1240 x 1240 pixels; wide-field contact fundus photograph of an infant: 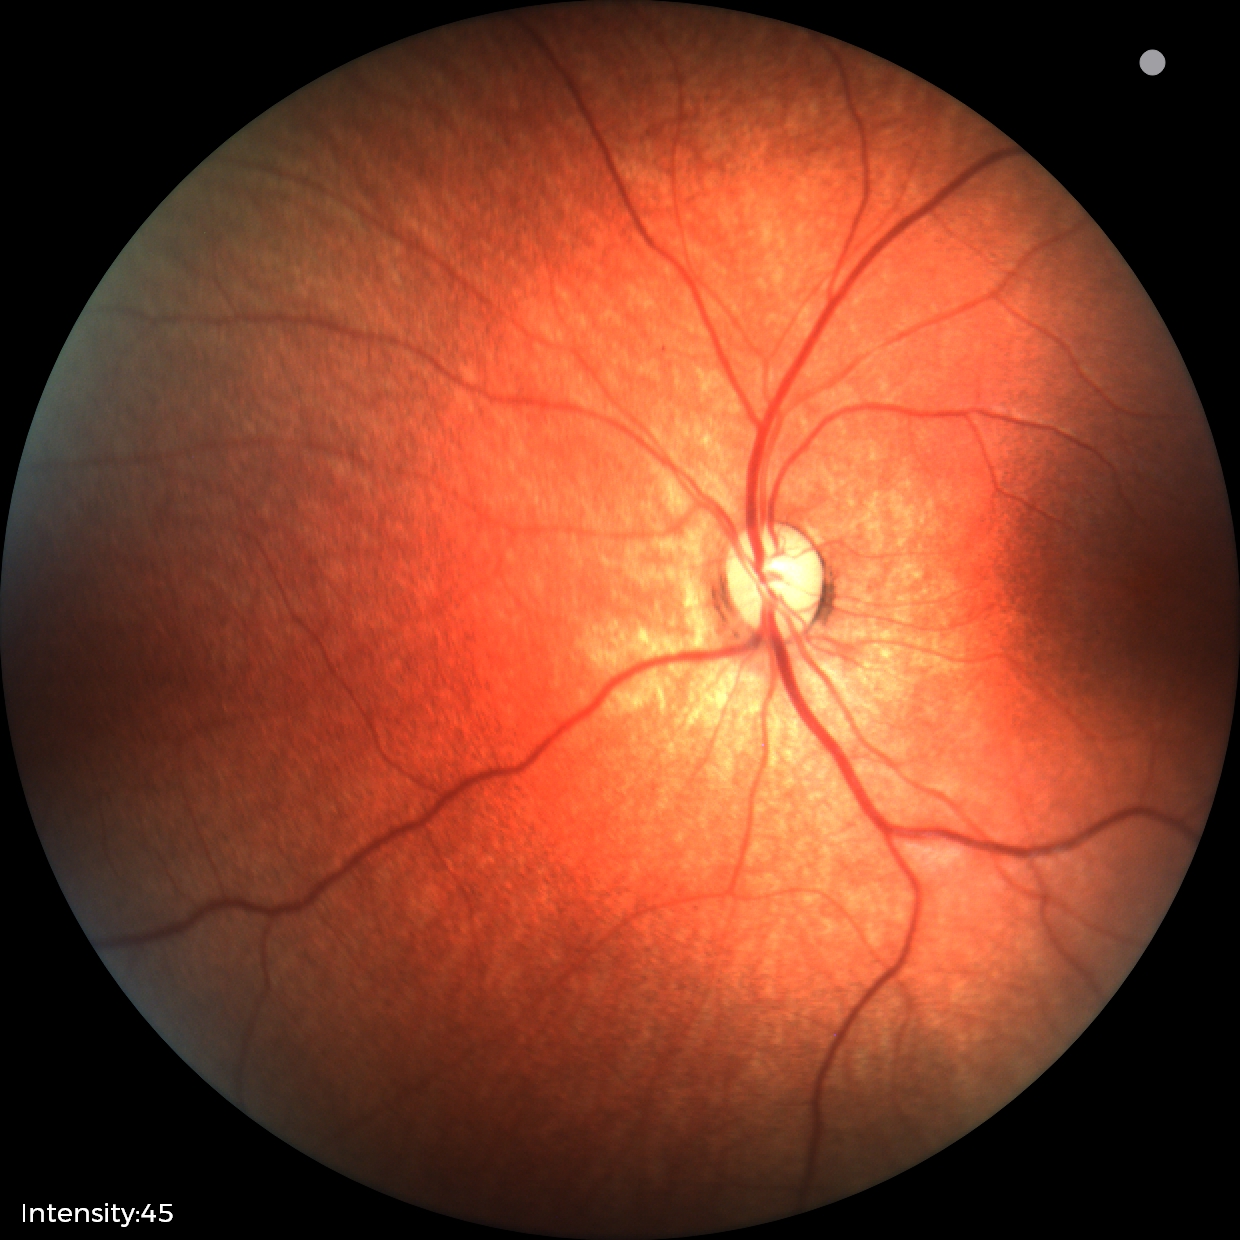

Normal screening examination.